Wide-field fundus image from infant ROP screening:
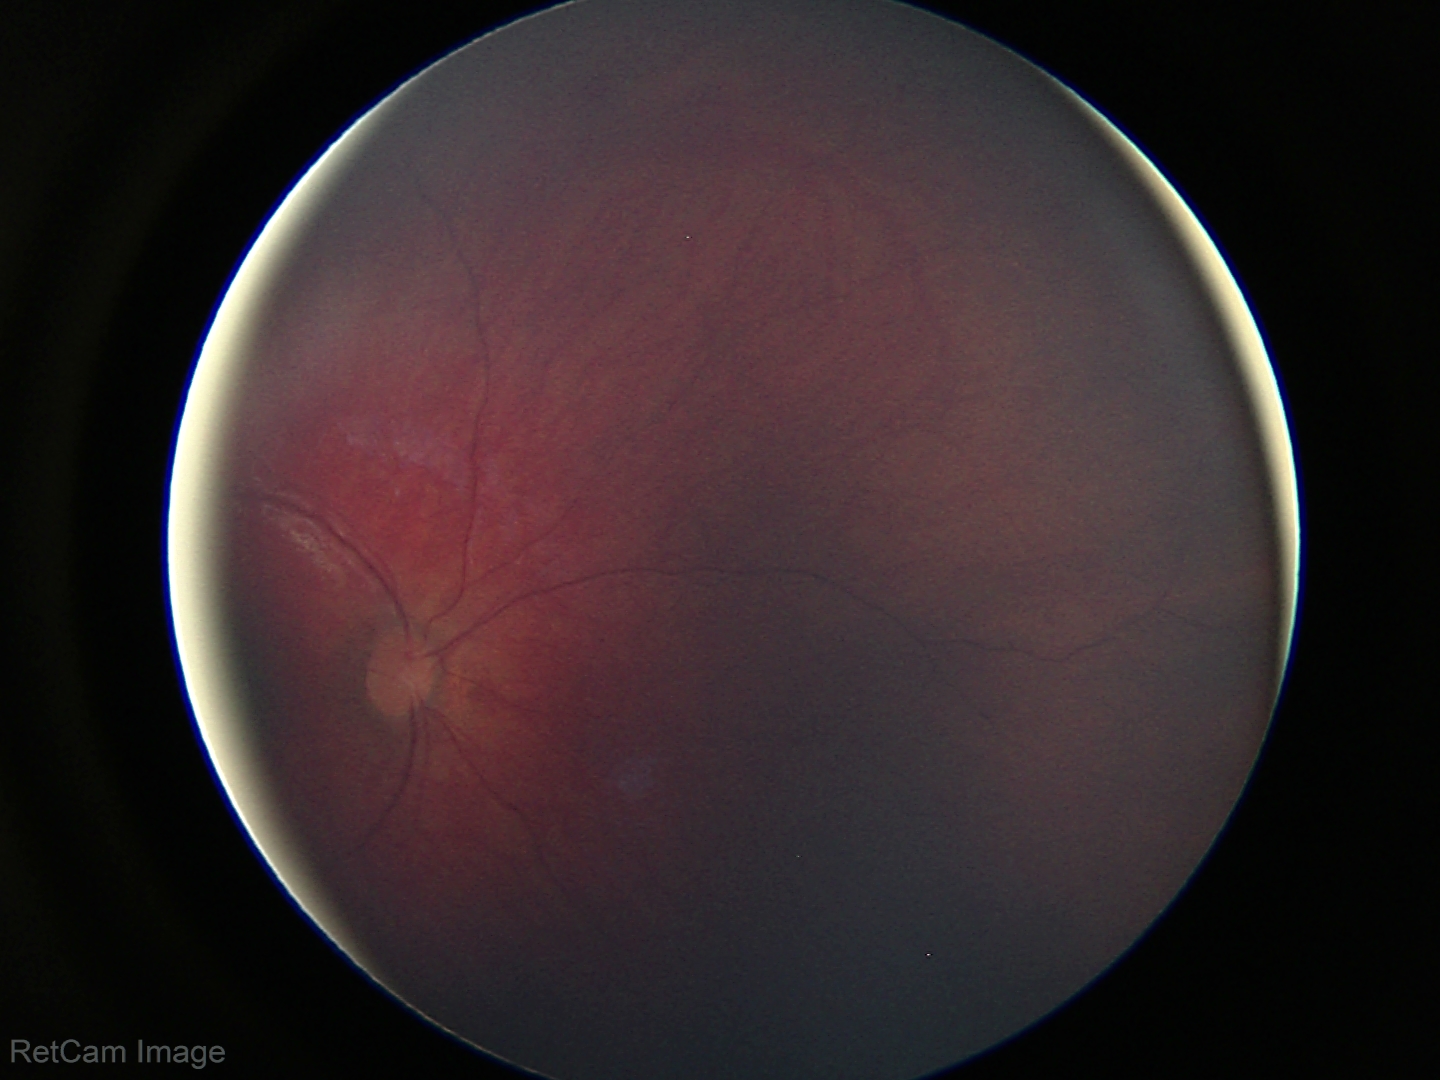

No retinal pathology identified on screening.